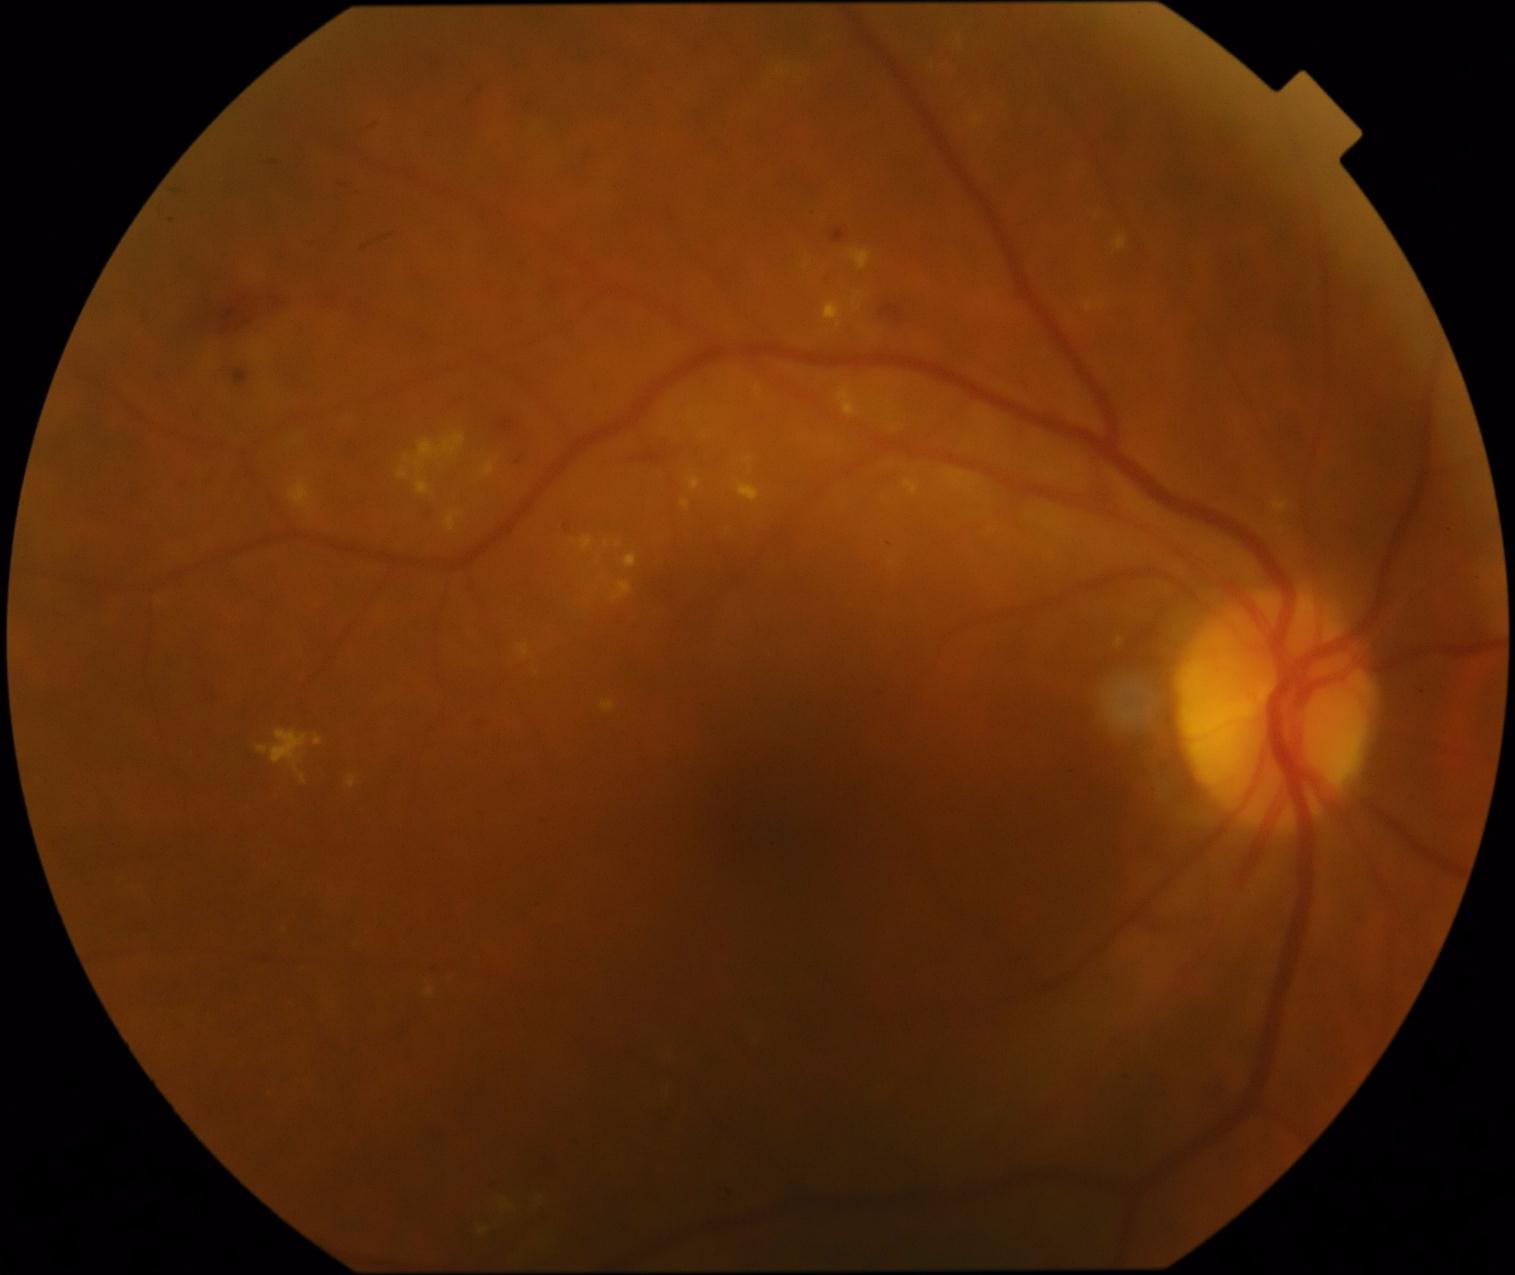
DR grade is moderate non-proliferative diabetic retinopathy (2). No MAs identified. HEs are located at (473, 717, 490, 732) | (612, 433, 706, 467) | (415, 507, 440, 526) | (1195, 1078, 1229, 1116) | (232, 369, 248, 388) | (879, 306, 904, 323) | (556, 511, 584, 542) | (521, 1156, 559, 1187) | (831, 229, 846, 244) | (536, 275, 571, 306) | (487, 414, 528, 453) | (194, 286, 285, 339) | (708, 1185, 738, 1207). Small HEs approximately at {"x": 519, "y": 463}. EXs include (346, 776, 357, 789) | (946, 470, 982, 494) | (580, 536, 594, 552) | (850, 250, 872, 272) | (904, 480, 919, 496) | (445, 511, 462, 533) | (1273, 501, 1289, 514) | (398, 467, 411, 480) | (314, 734, 323, 746) | (681, 501, 690, 510) | (1114, 235, 1126, 251) | (1117, 639, 1123, 648) | (288, 482, 311, 508) | (415, 476, 431, 497) | (258, 730, 308, 784). Small EXs approximately at {"x": 1282, "y": 530} | {"x": 691, "y": 416} | {"x": 892, "y": 411} | {"x": 619, "y": 545} | {"x": 483, "y": 1232}. No SEs identified.